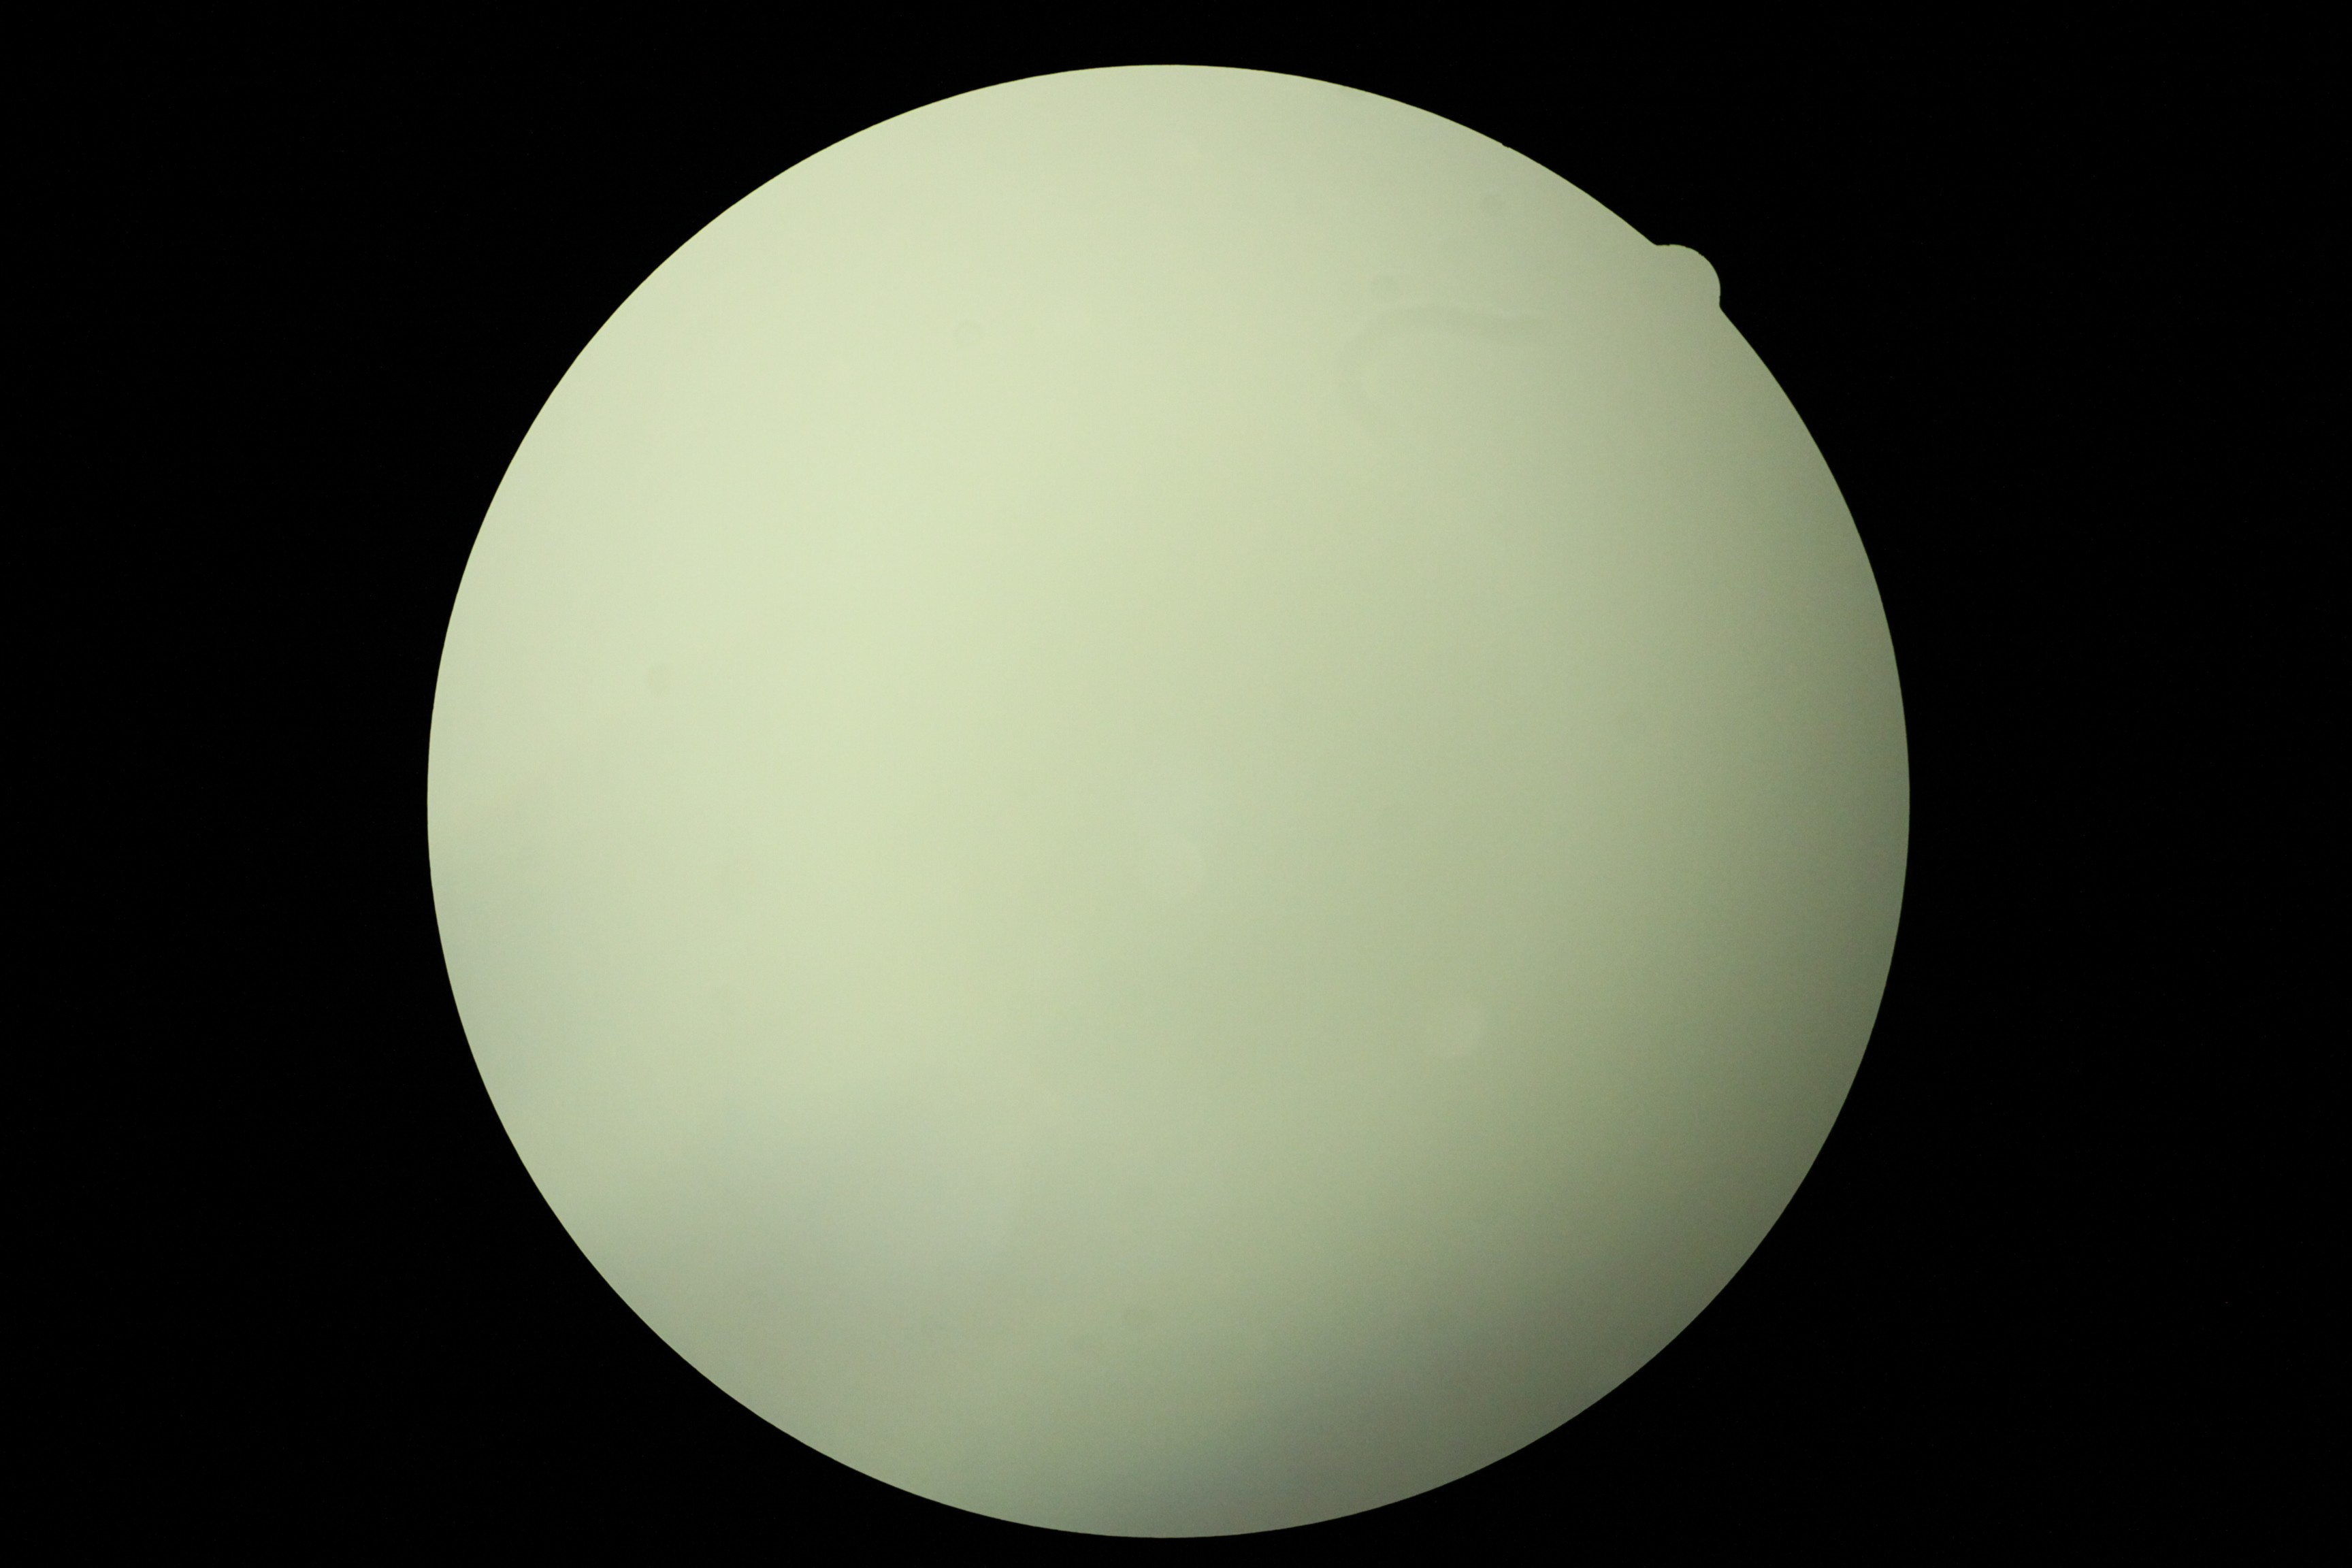

DR severity is ungradable. Ungradable image — DR severity cannot be determined.